Color fundus photograph
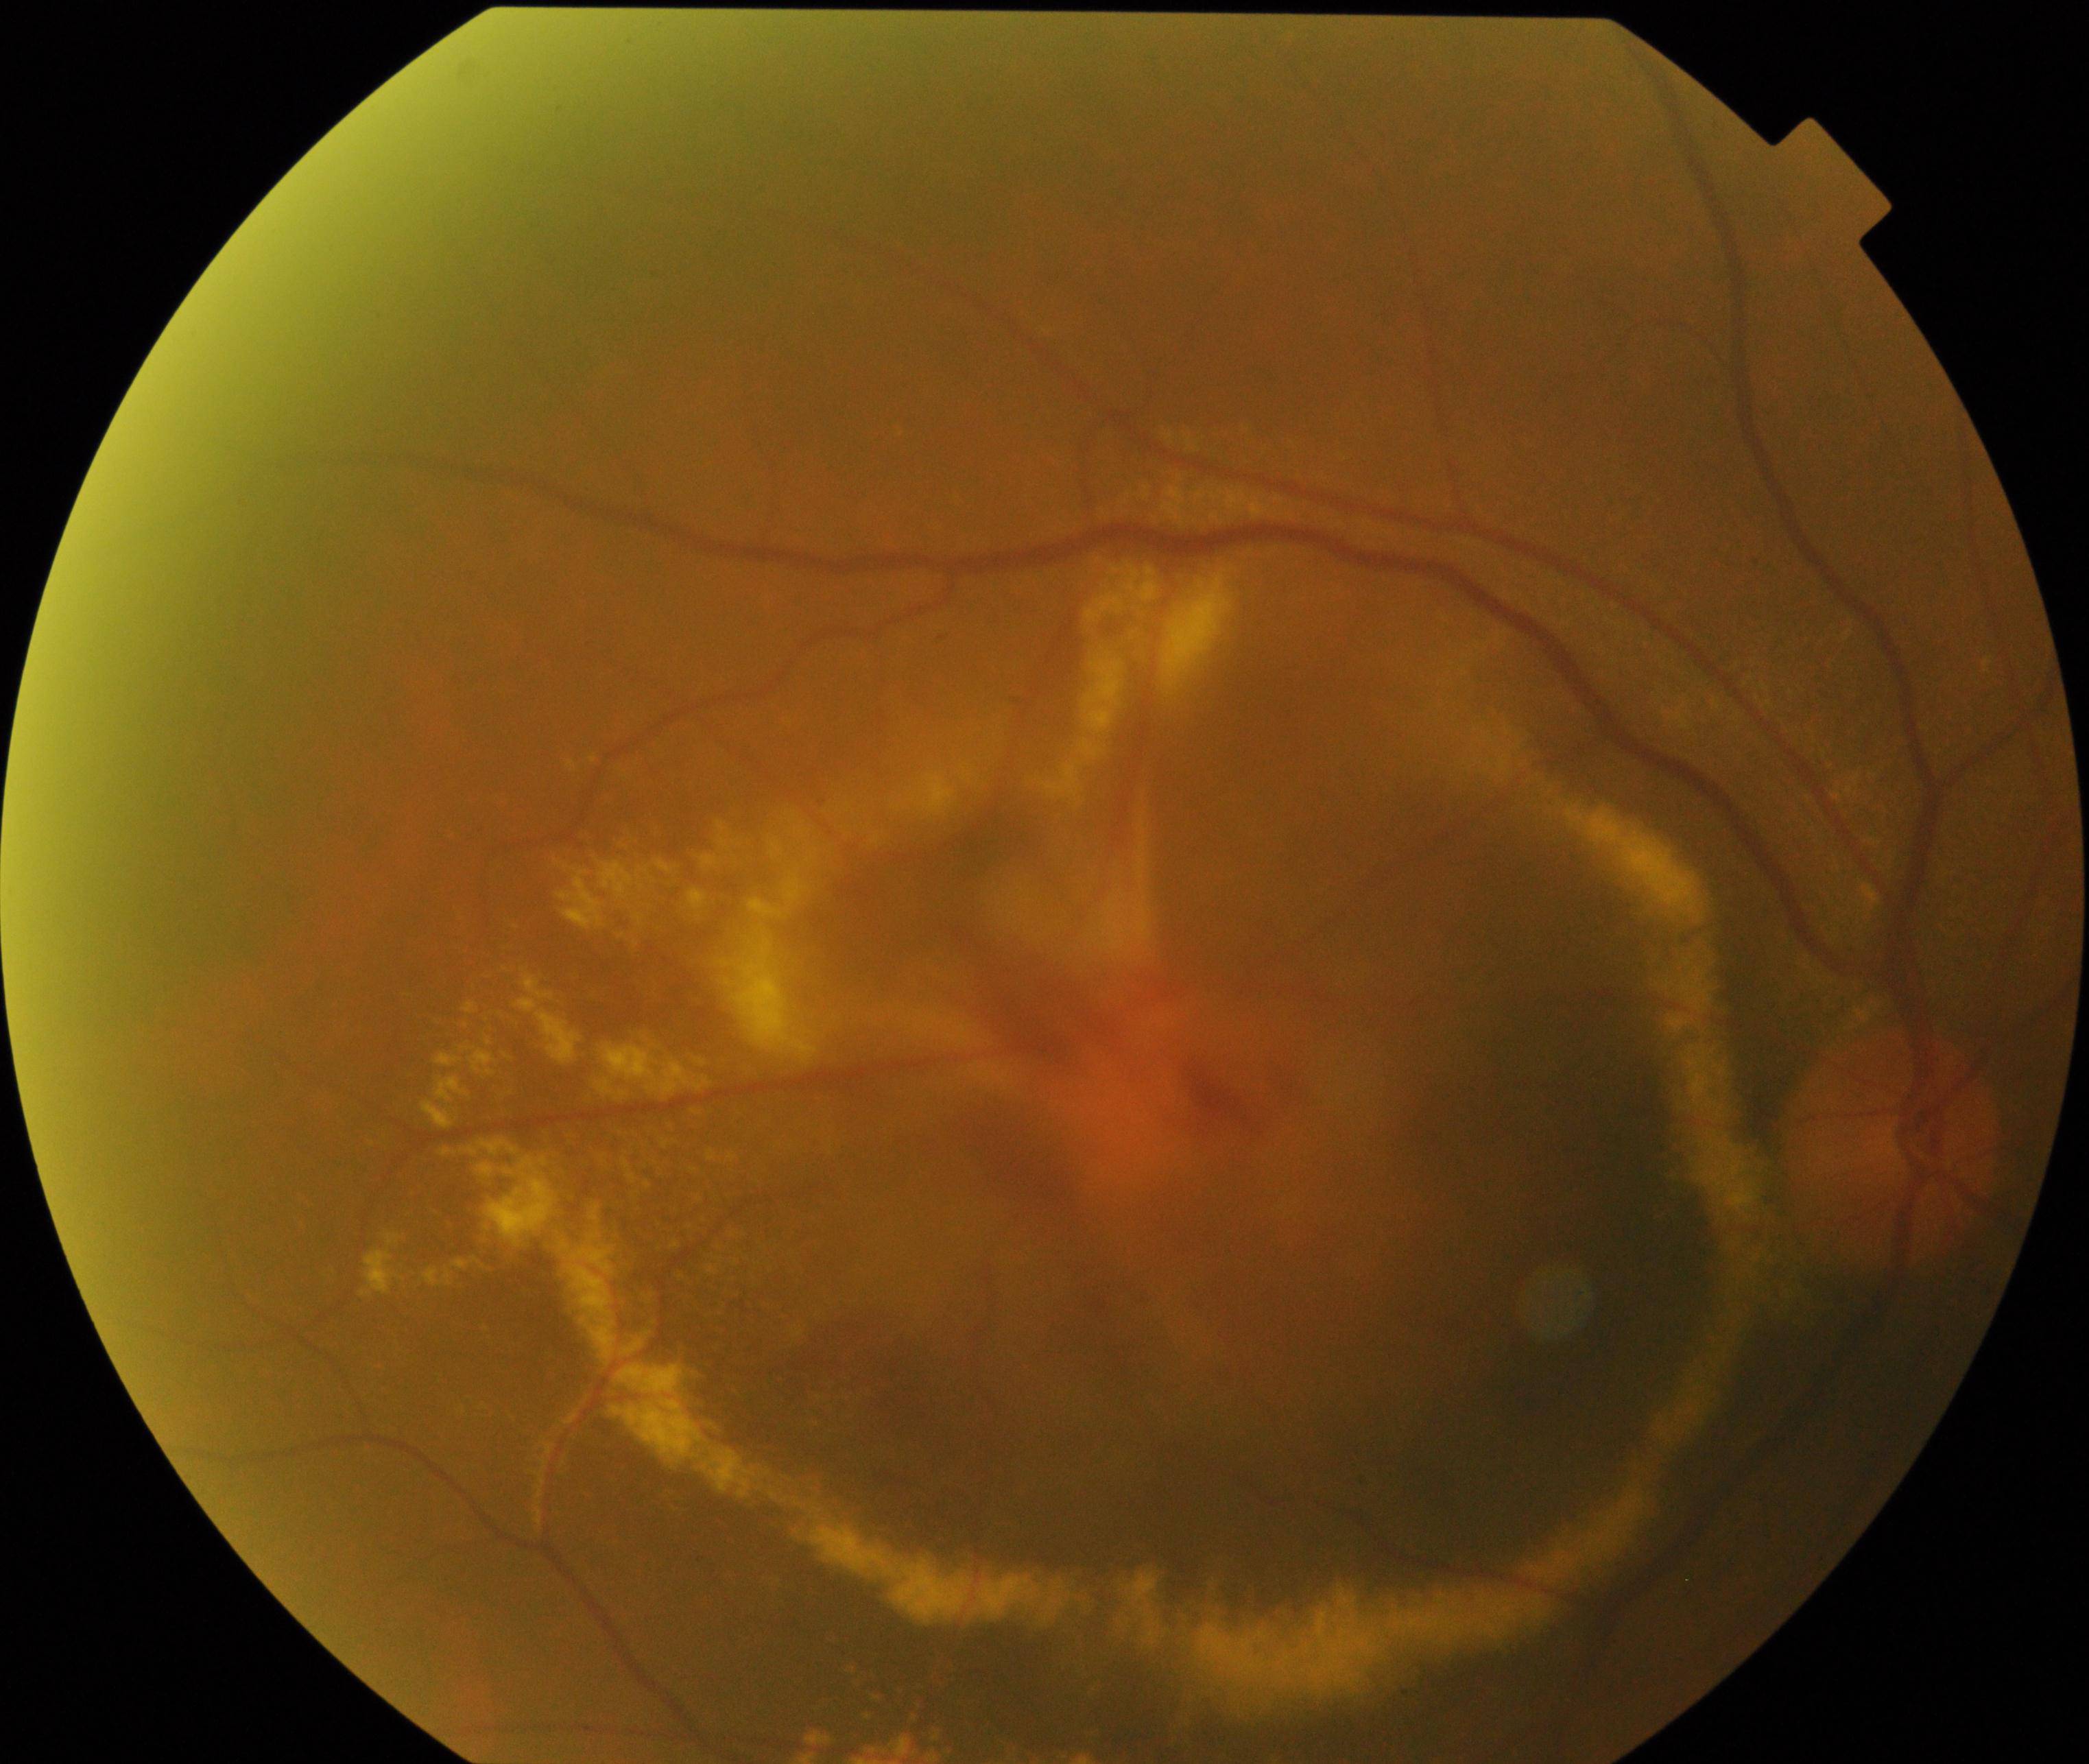

Diagnosis: maculopathy.